45° FOV · NIDEK AFC-230.
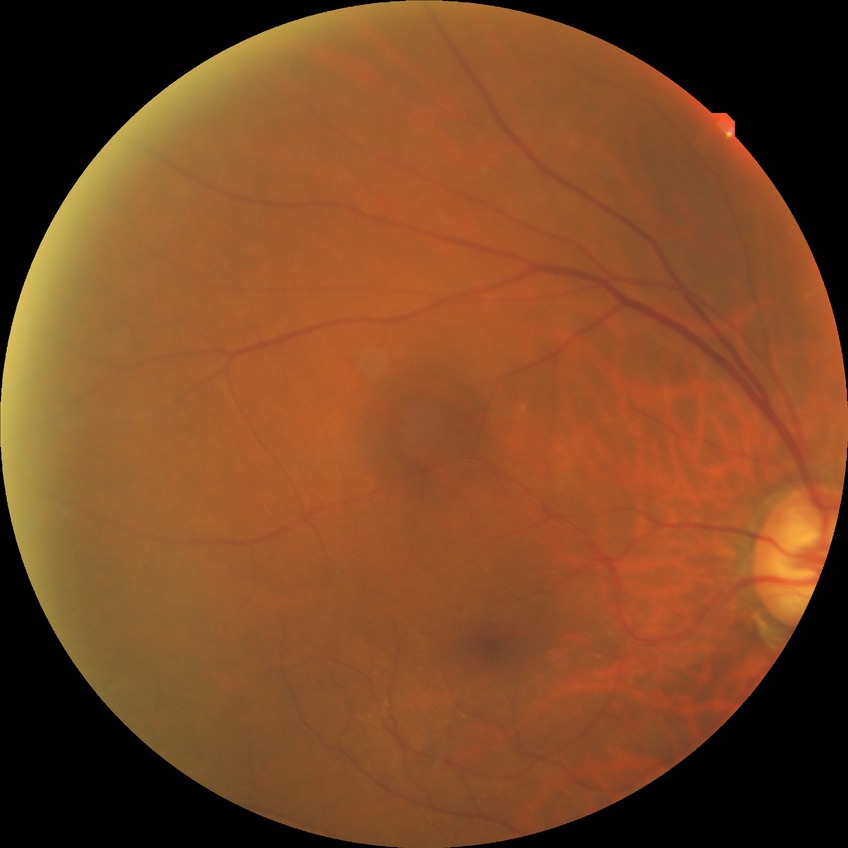
{
  "davis_grade": "no diabetic retinopathy (NDR)"
}